Graded on the modified Davis scale
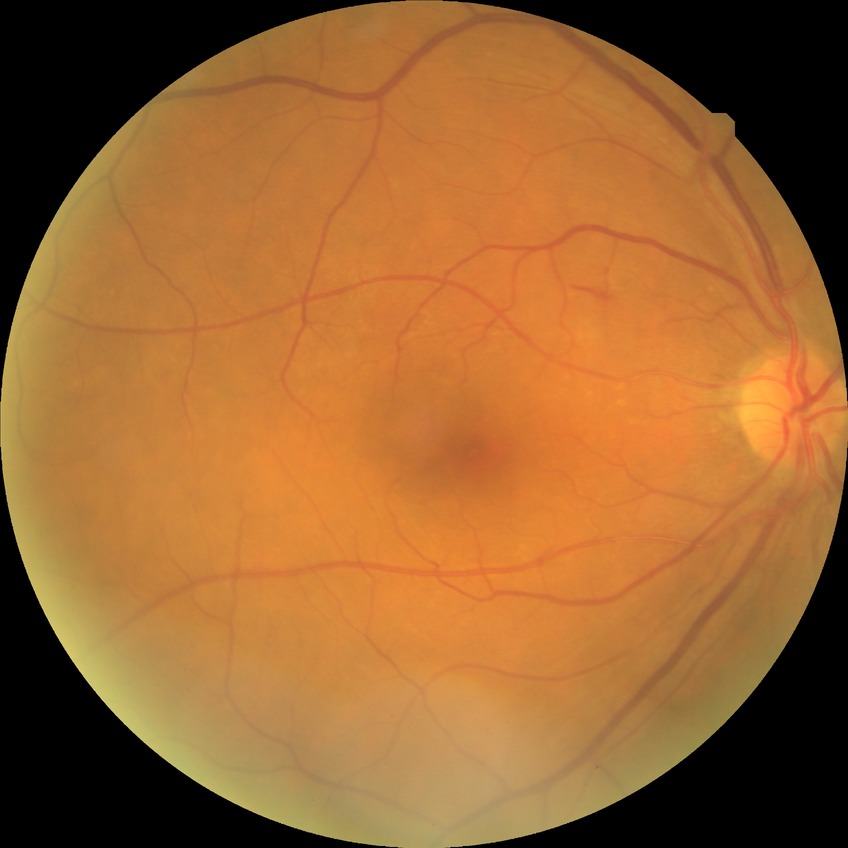

Diabetic retinopathy (DR) is PPDR (pre-proliferative diabetic retinopathy). Disease class: non-proliferative diabetic retinopathy.